DR severity per modified Davis staging.
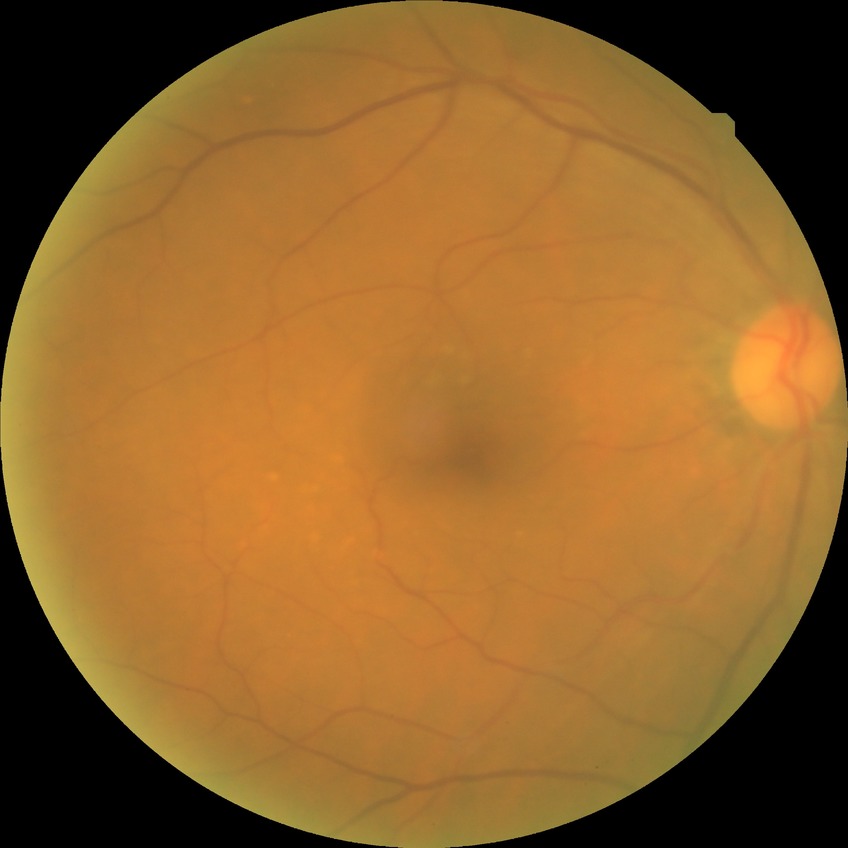

DR stage is NDR.